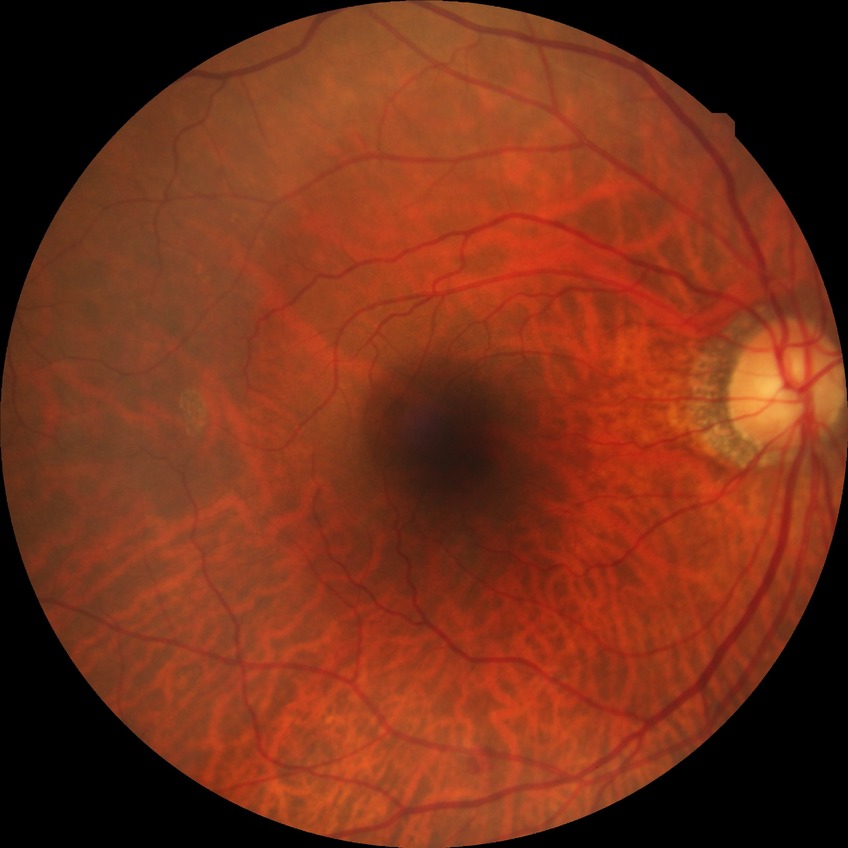 davis_grade: simple diabetic retinopathy (SDR)